FOV: 50 degrees
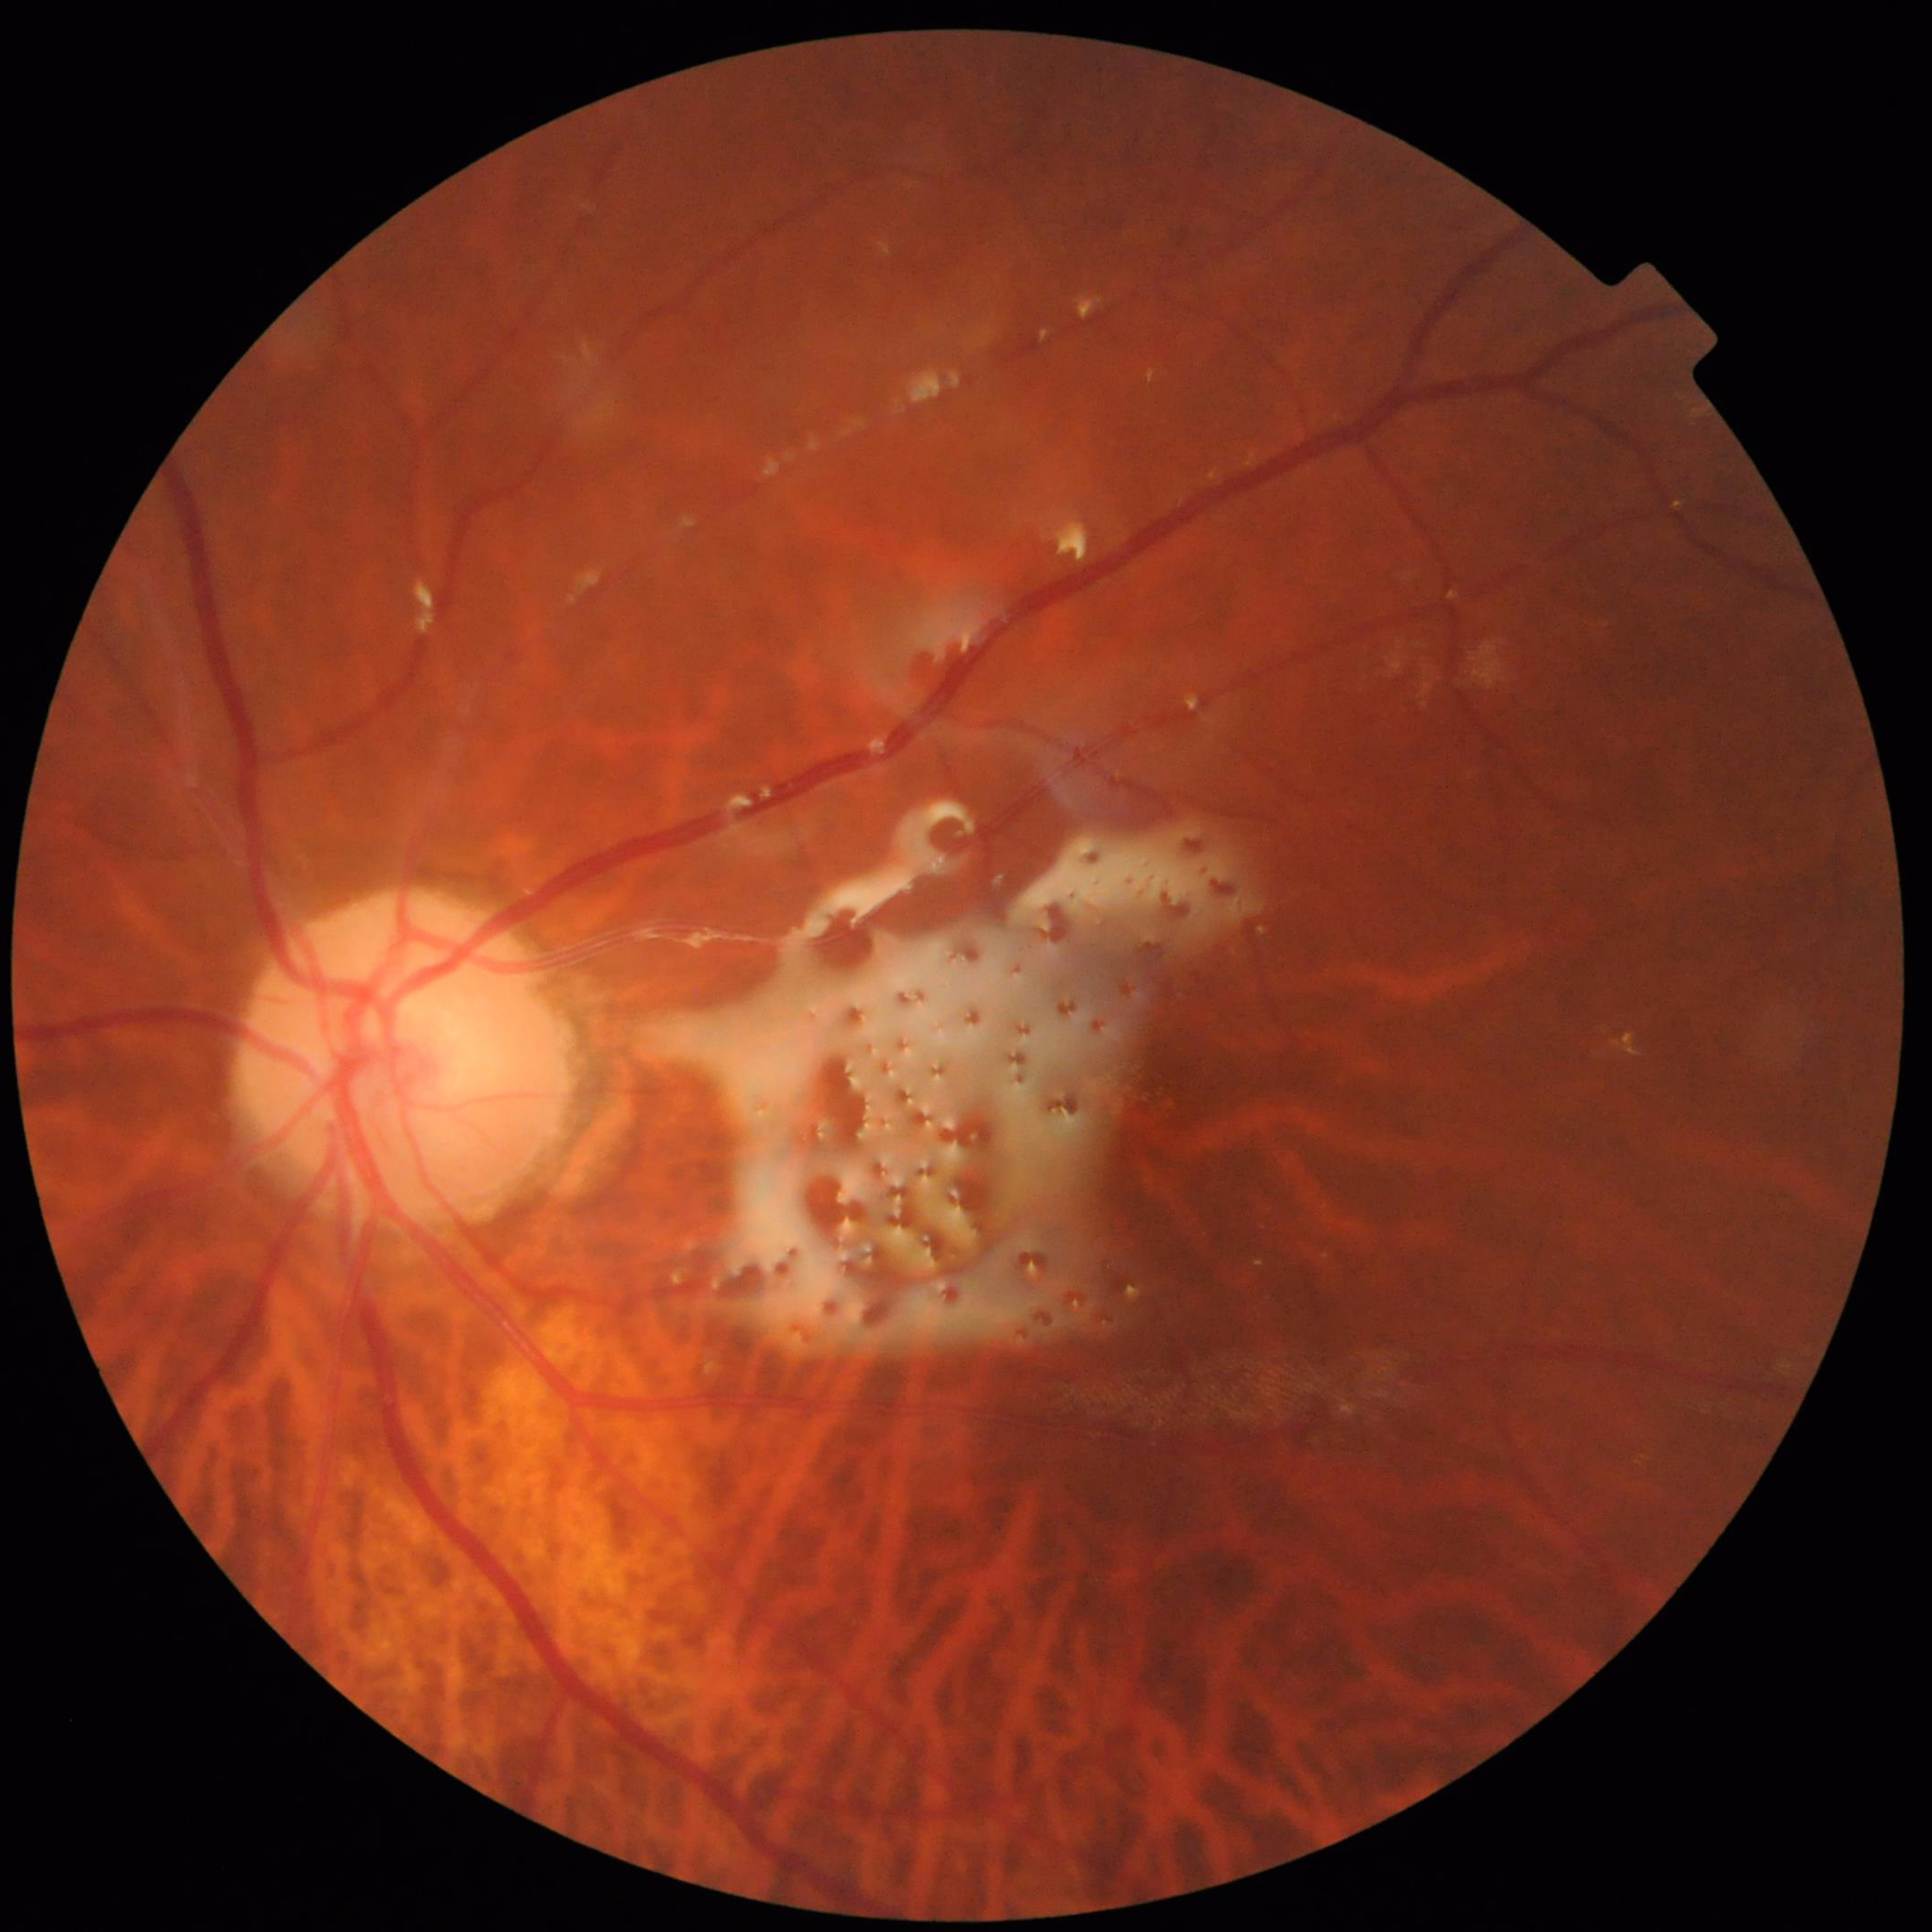
Impression: diabetic retinopathy (DR)